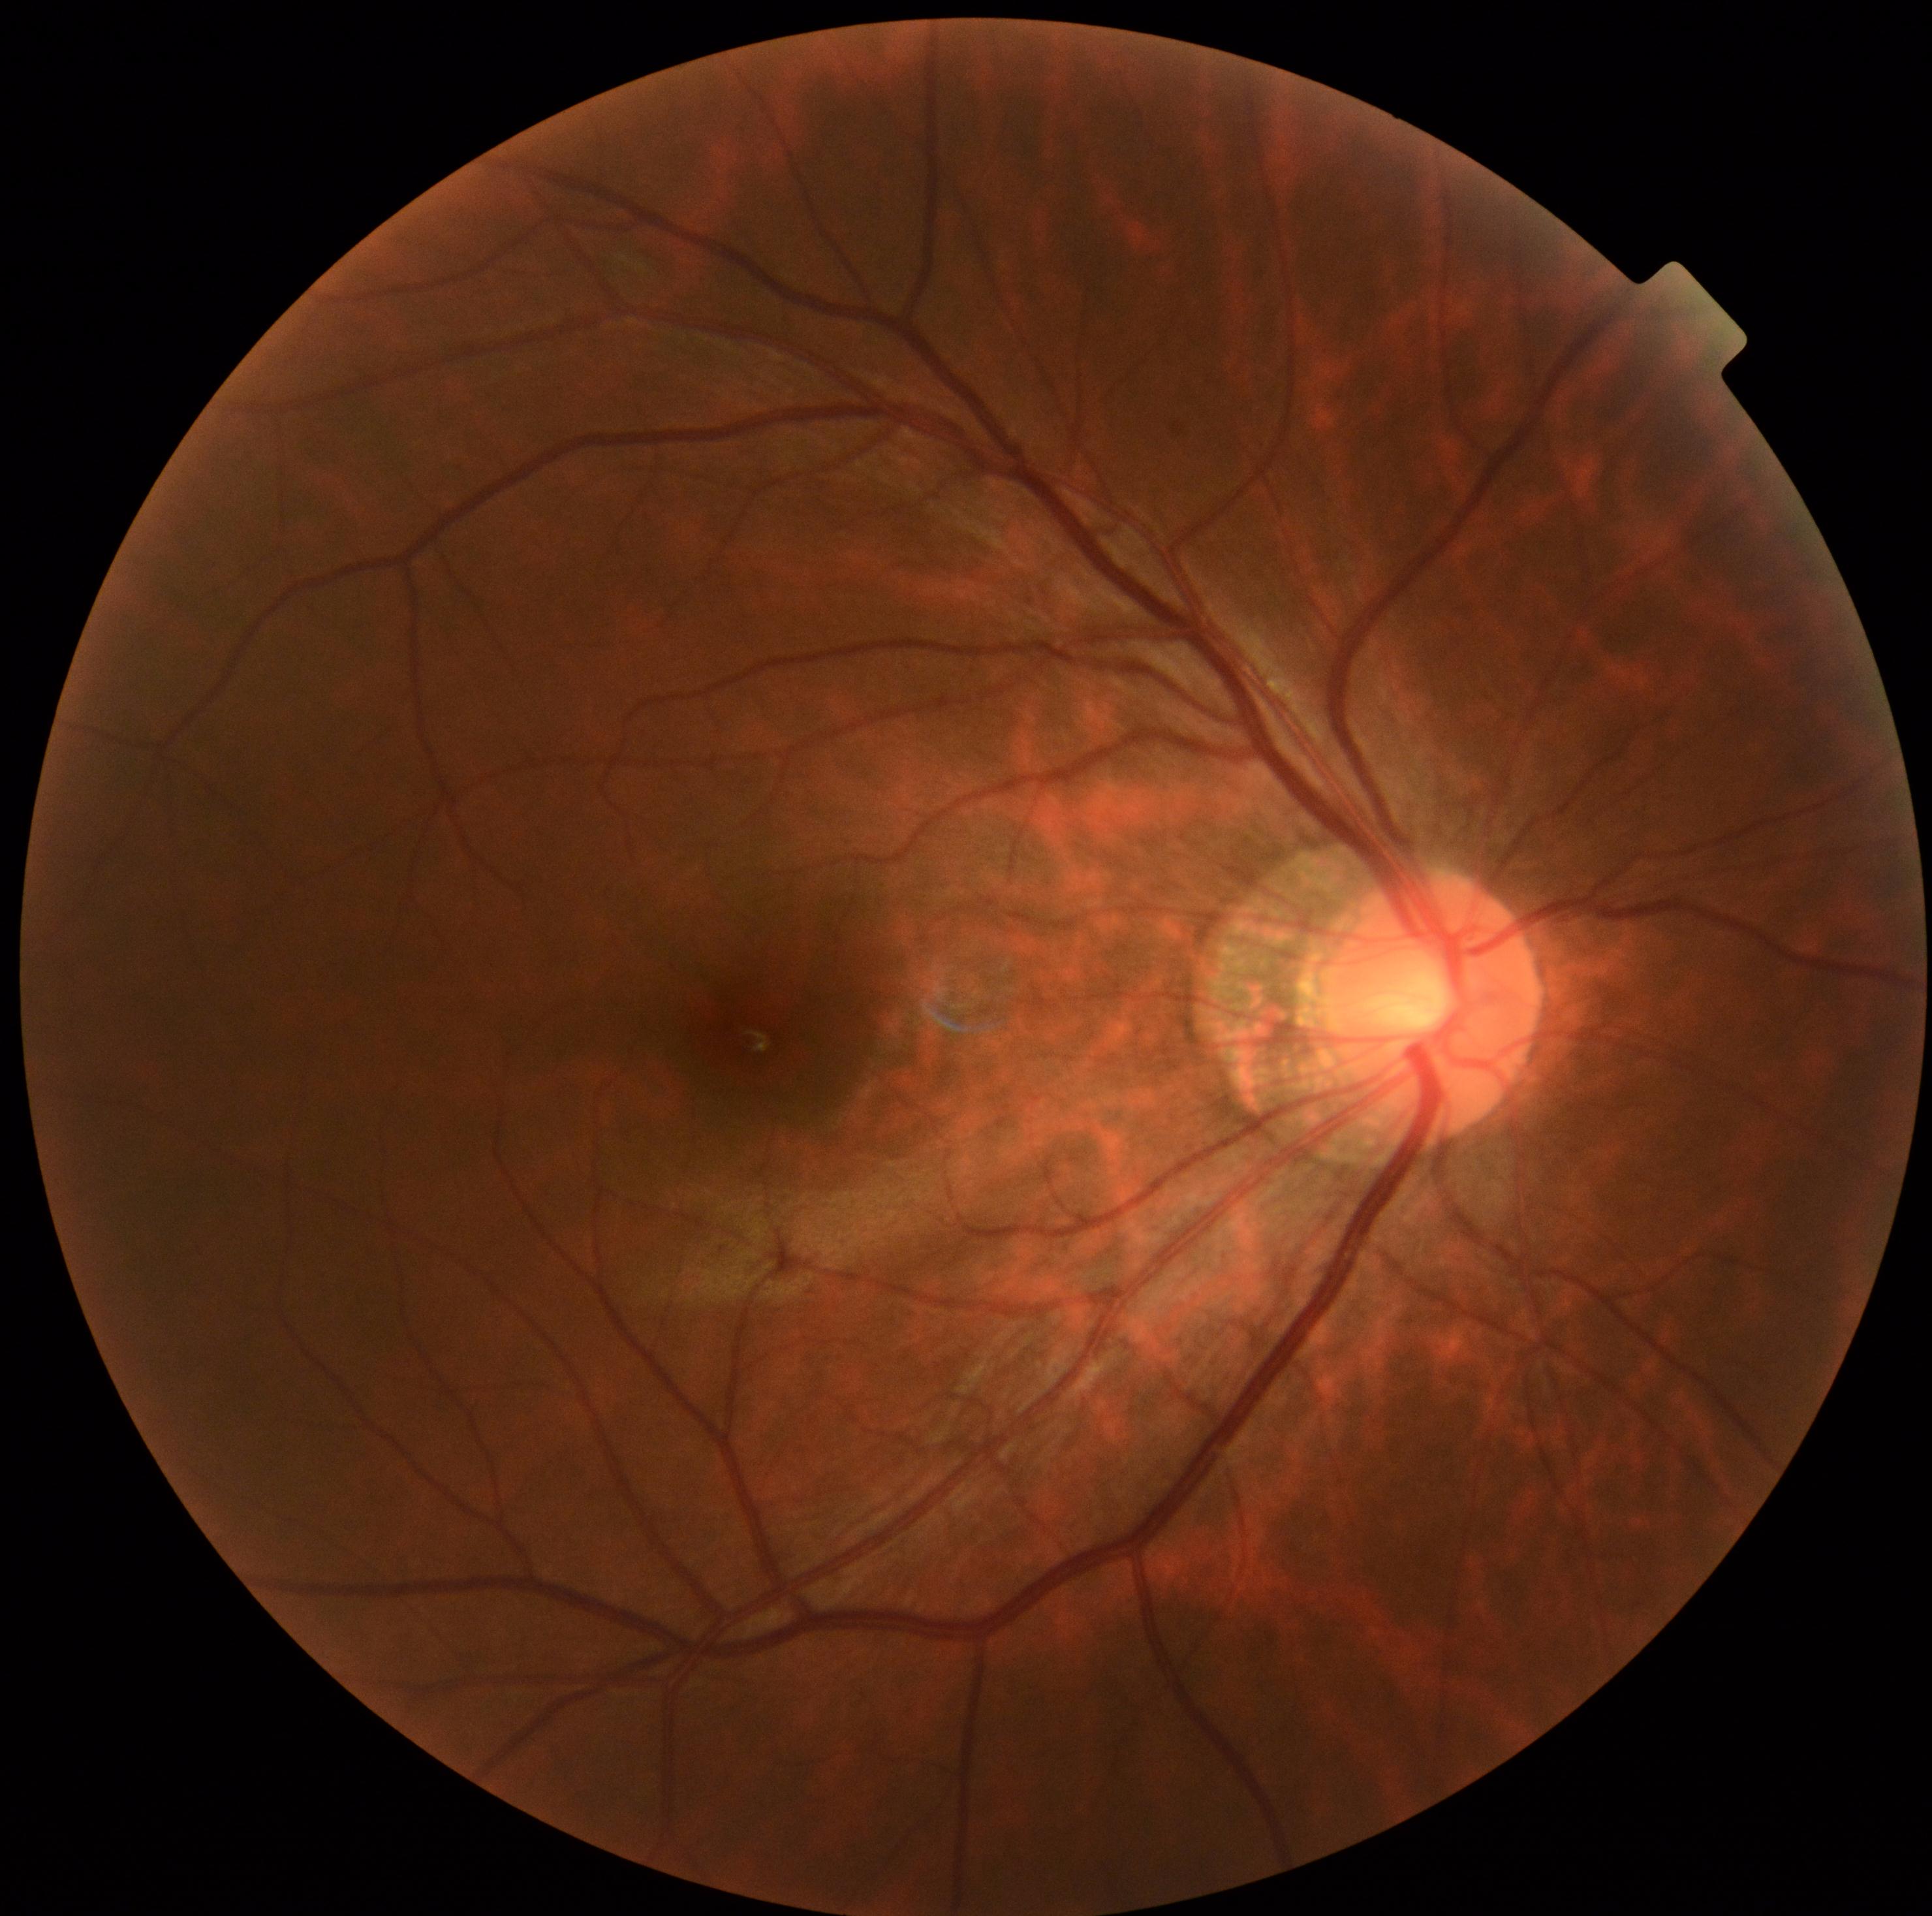
diabetic retinopathy grade = no apparent retinopathy (0); DR impression = no DR findings.